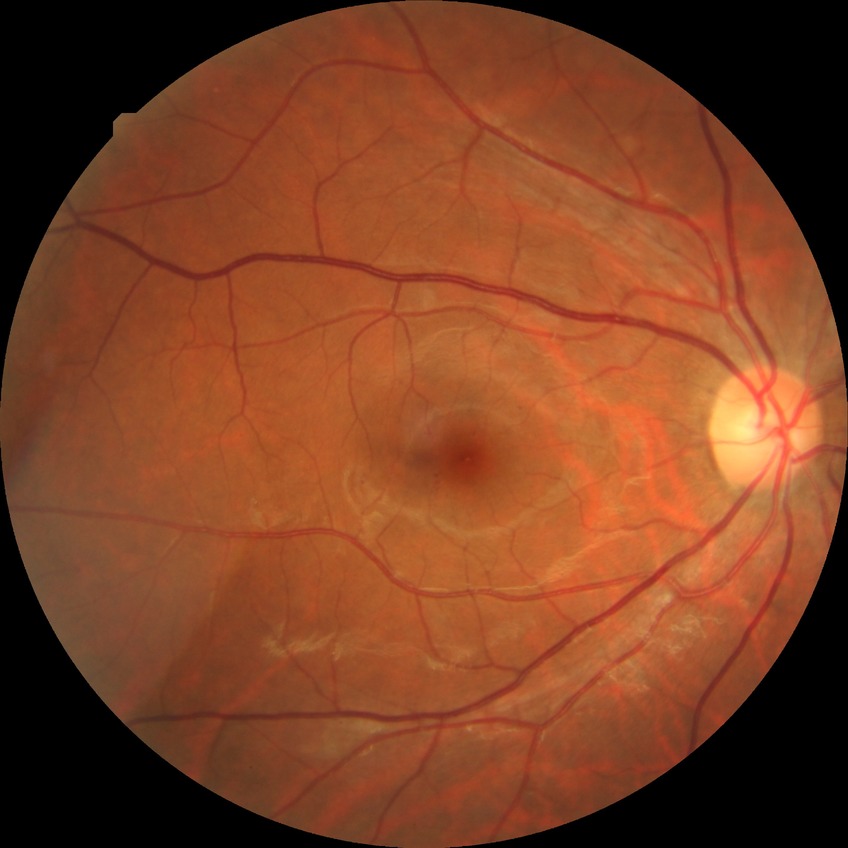
  davis_grade: simple diabetic retinopathy